CFP: 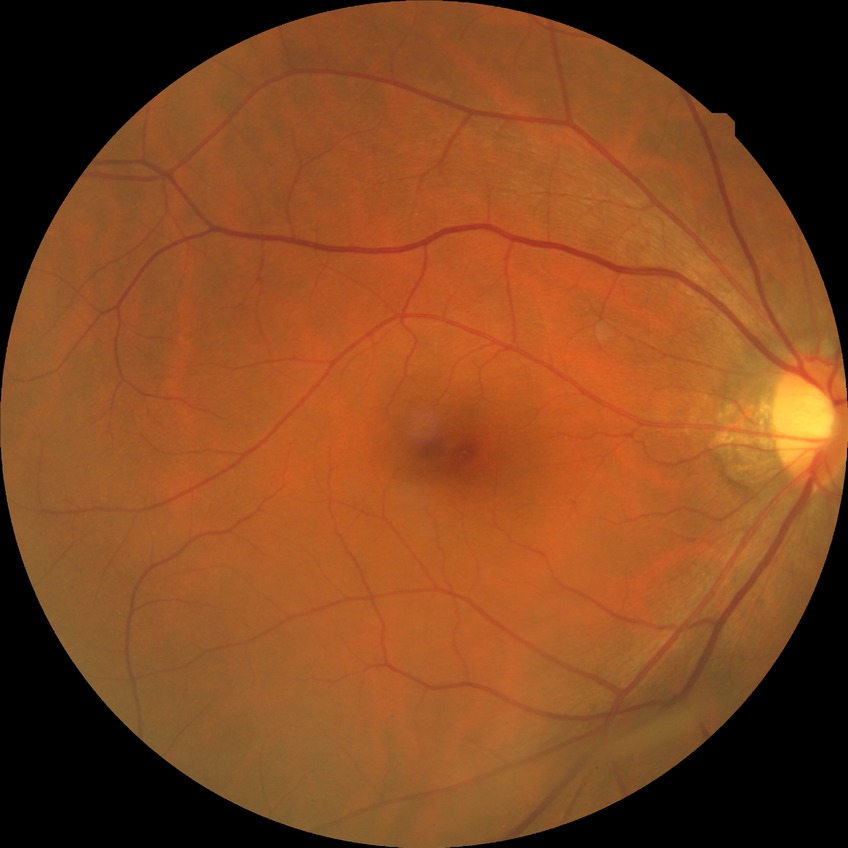
davis_grade: no diabetic retinopathy